Davis DR grading; 45° FOV: 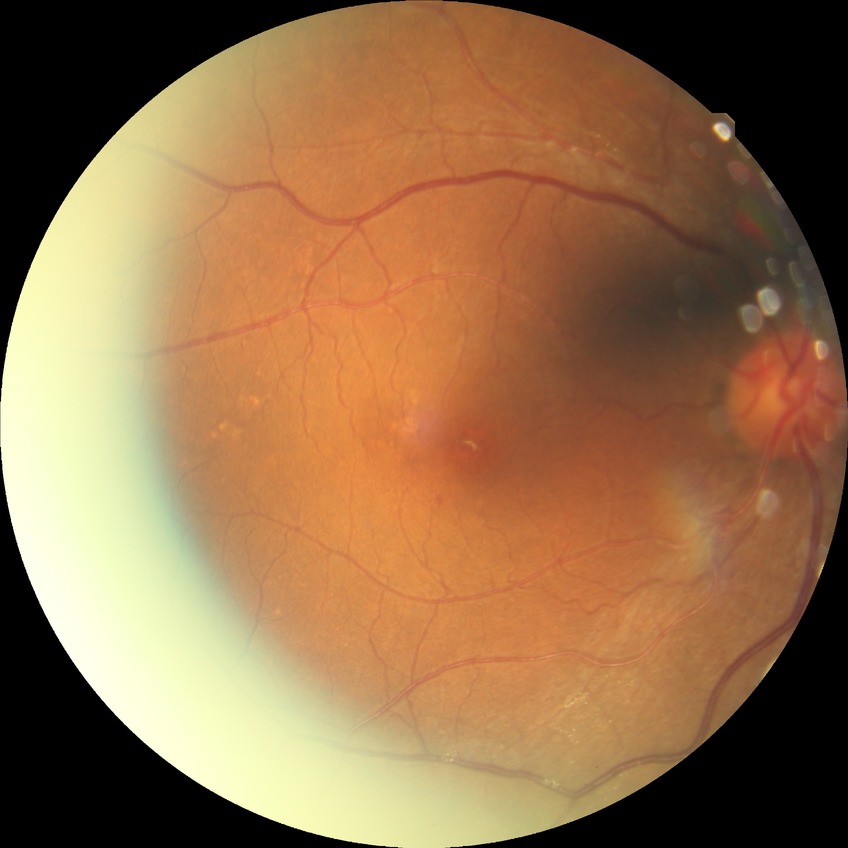 Diabetic retinopathy (DR): no diabetic retinopathy (NDR).